2352 x 1568 pixels, retinal fundus photograph, 45° FOV: 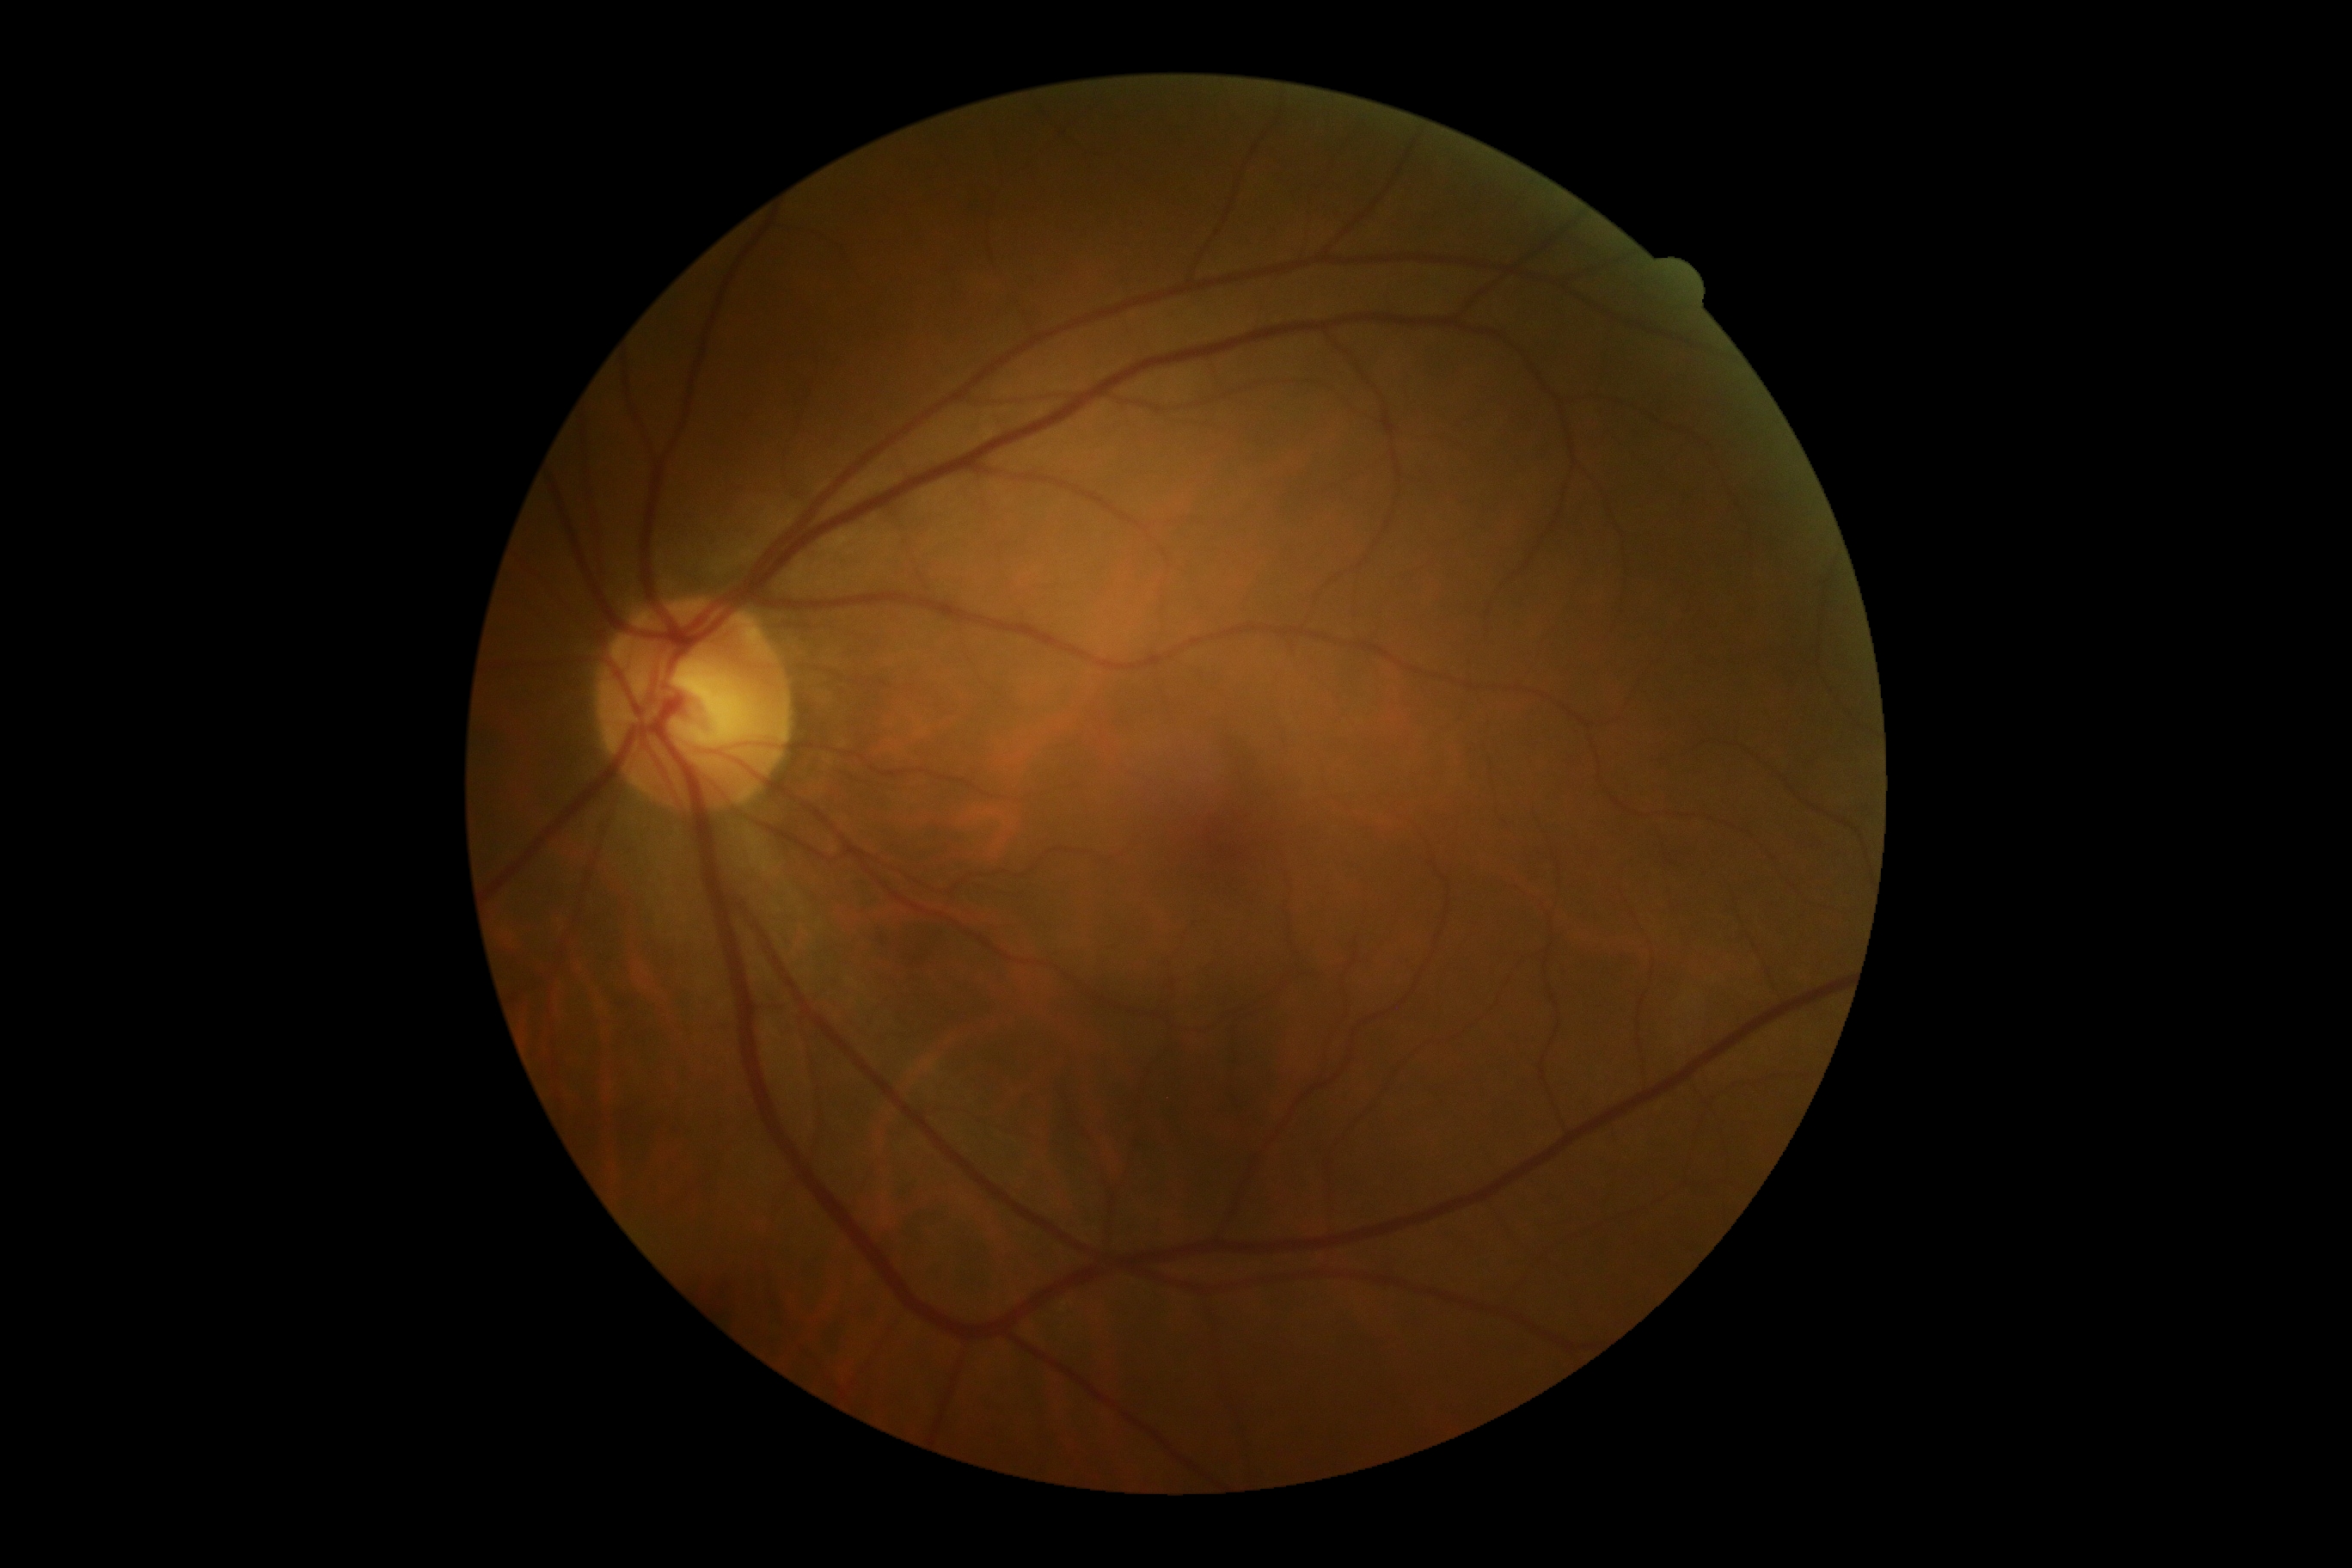 Diabetic retinopathy grade is no apparent diabetic retinopathy (0).